Infant wide-field fundus photograph: 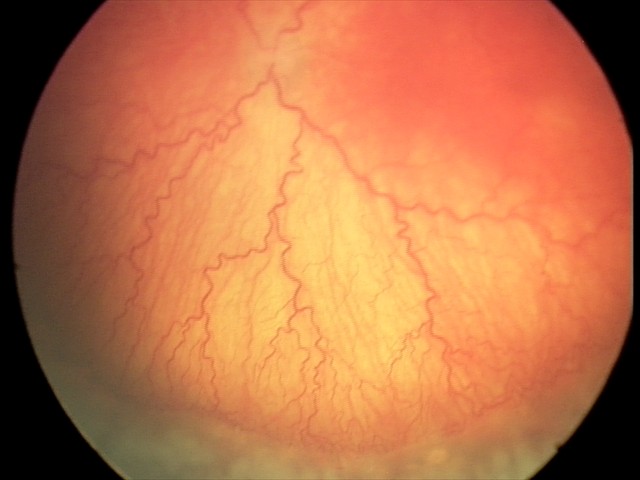

Impression: plus disease | aggressive ROP (A-ROP).